Image size 848x848. Without pupil dilation. Retinal fundus photograph. NIDEK AFC-230. FOV: 45 degrees. DR severity per modified Davis staging.
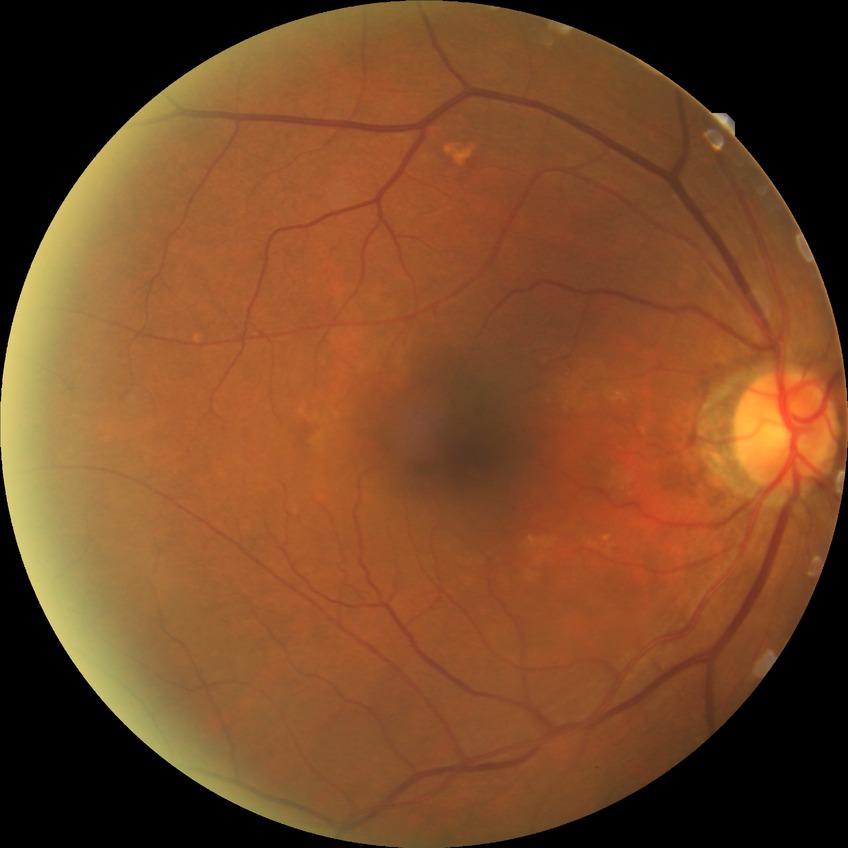 DR is NDR.